45° FOV, 1536x1152:
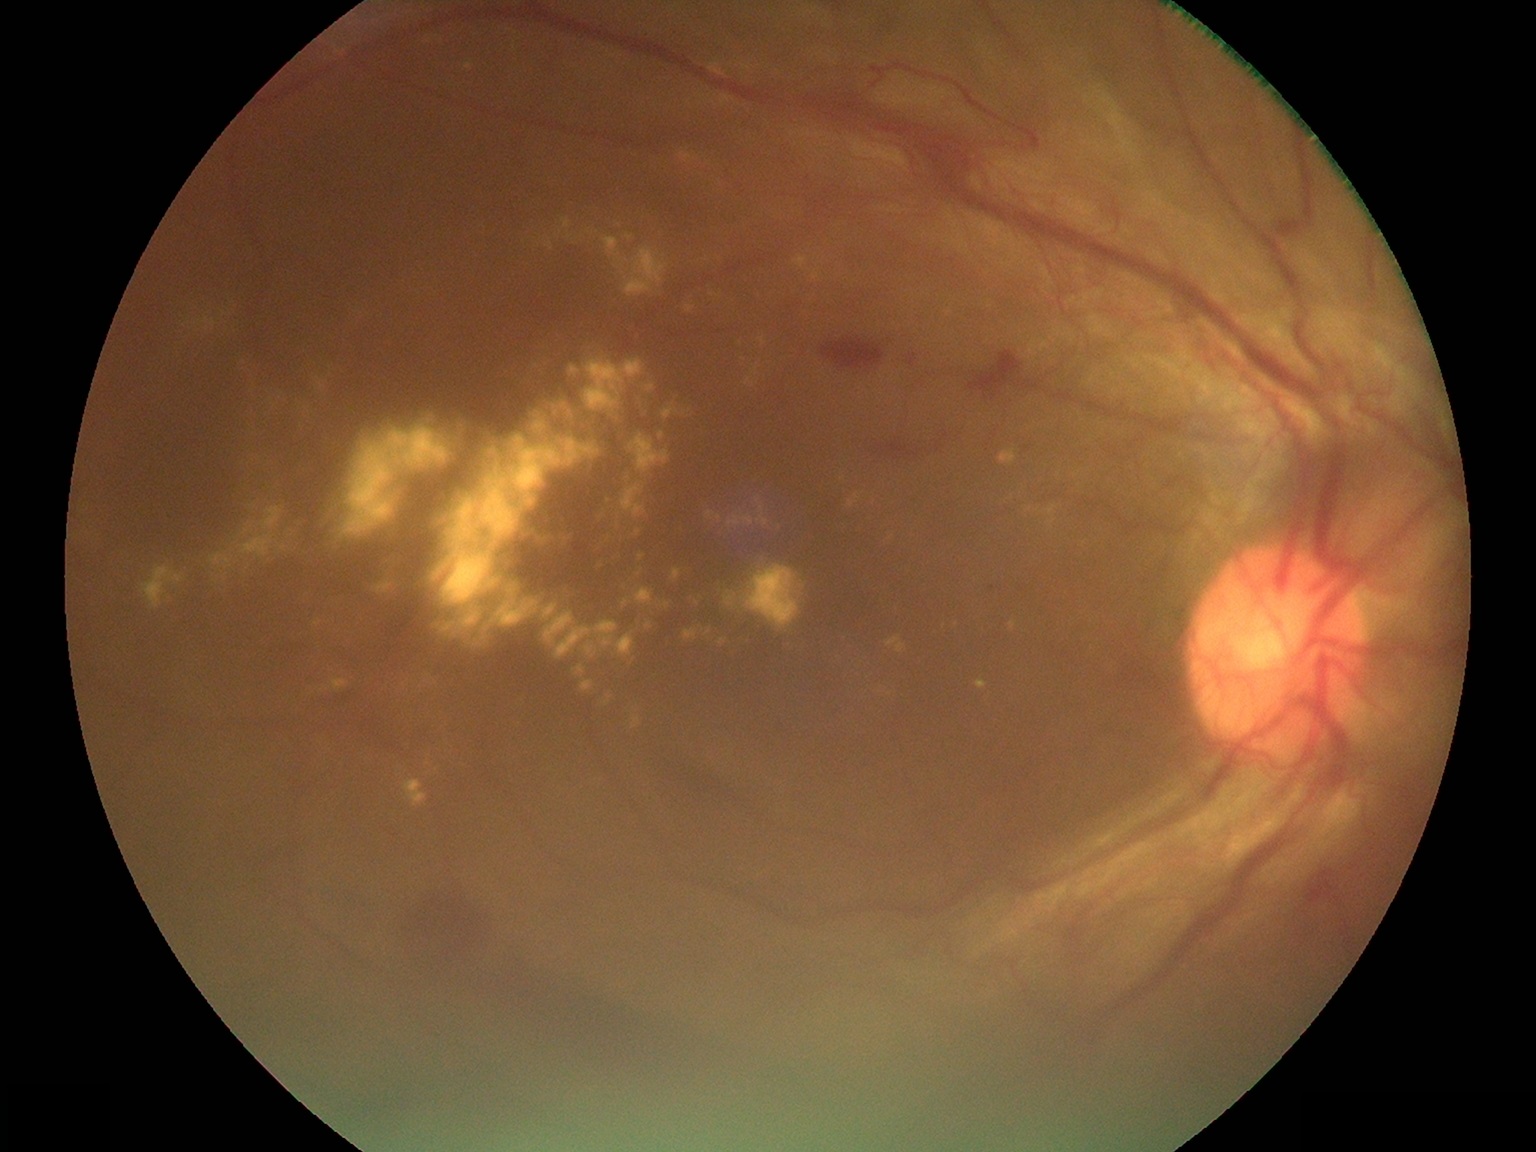 <lesions partial="true">
  <dr_grade>4</dr_grade>
  <ex partial="true">560,534,574,546; 542,537,552,545; 540,236,553,252; 889,533,893,541; 635,586,654,607; 626,476,632,485; 317,677,350,695; 680,150,698,166; 717,638,728,647; 603,237,669,298; 221,311,233,320; 976,678,988,689; 683,409,692,416</ex>
  <ex_small>[697,603]; [405,686]; [886,690]; [703,631]; [957,624]</ex_small>
</lesions>